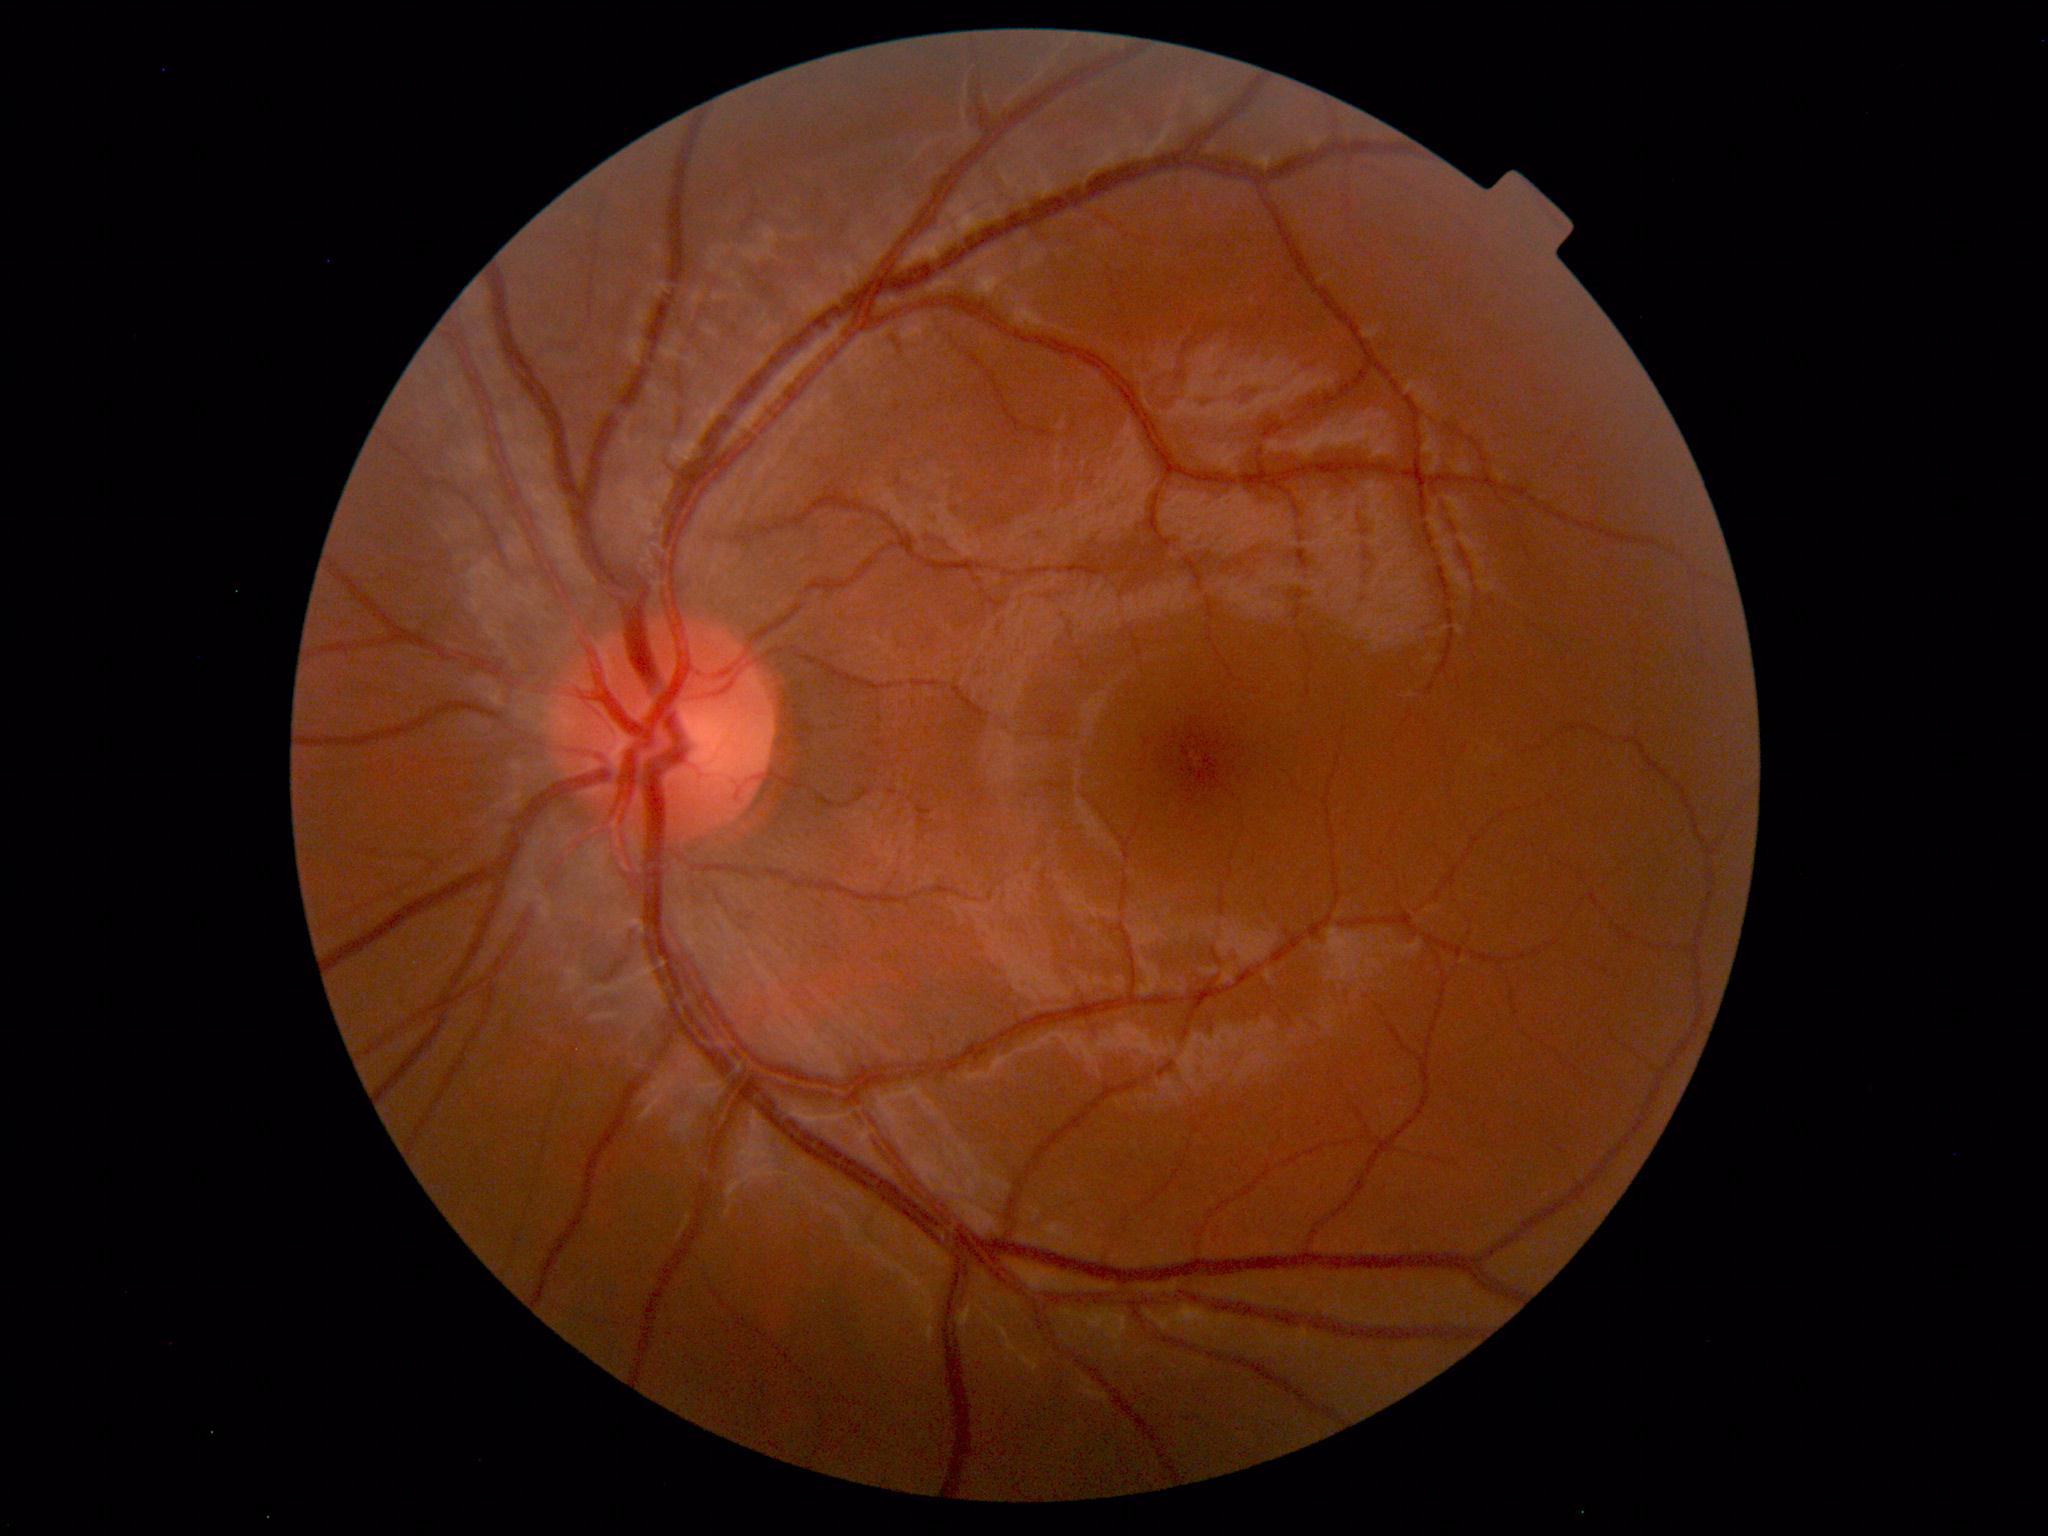
Impression: normal fundus.